2352x1568px, retinal fundus photograph
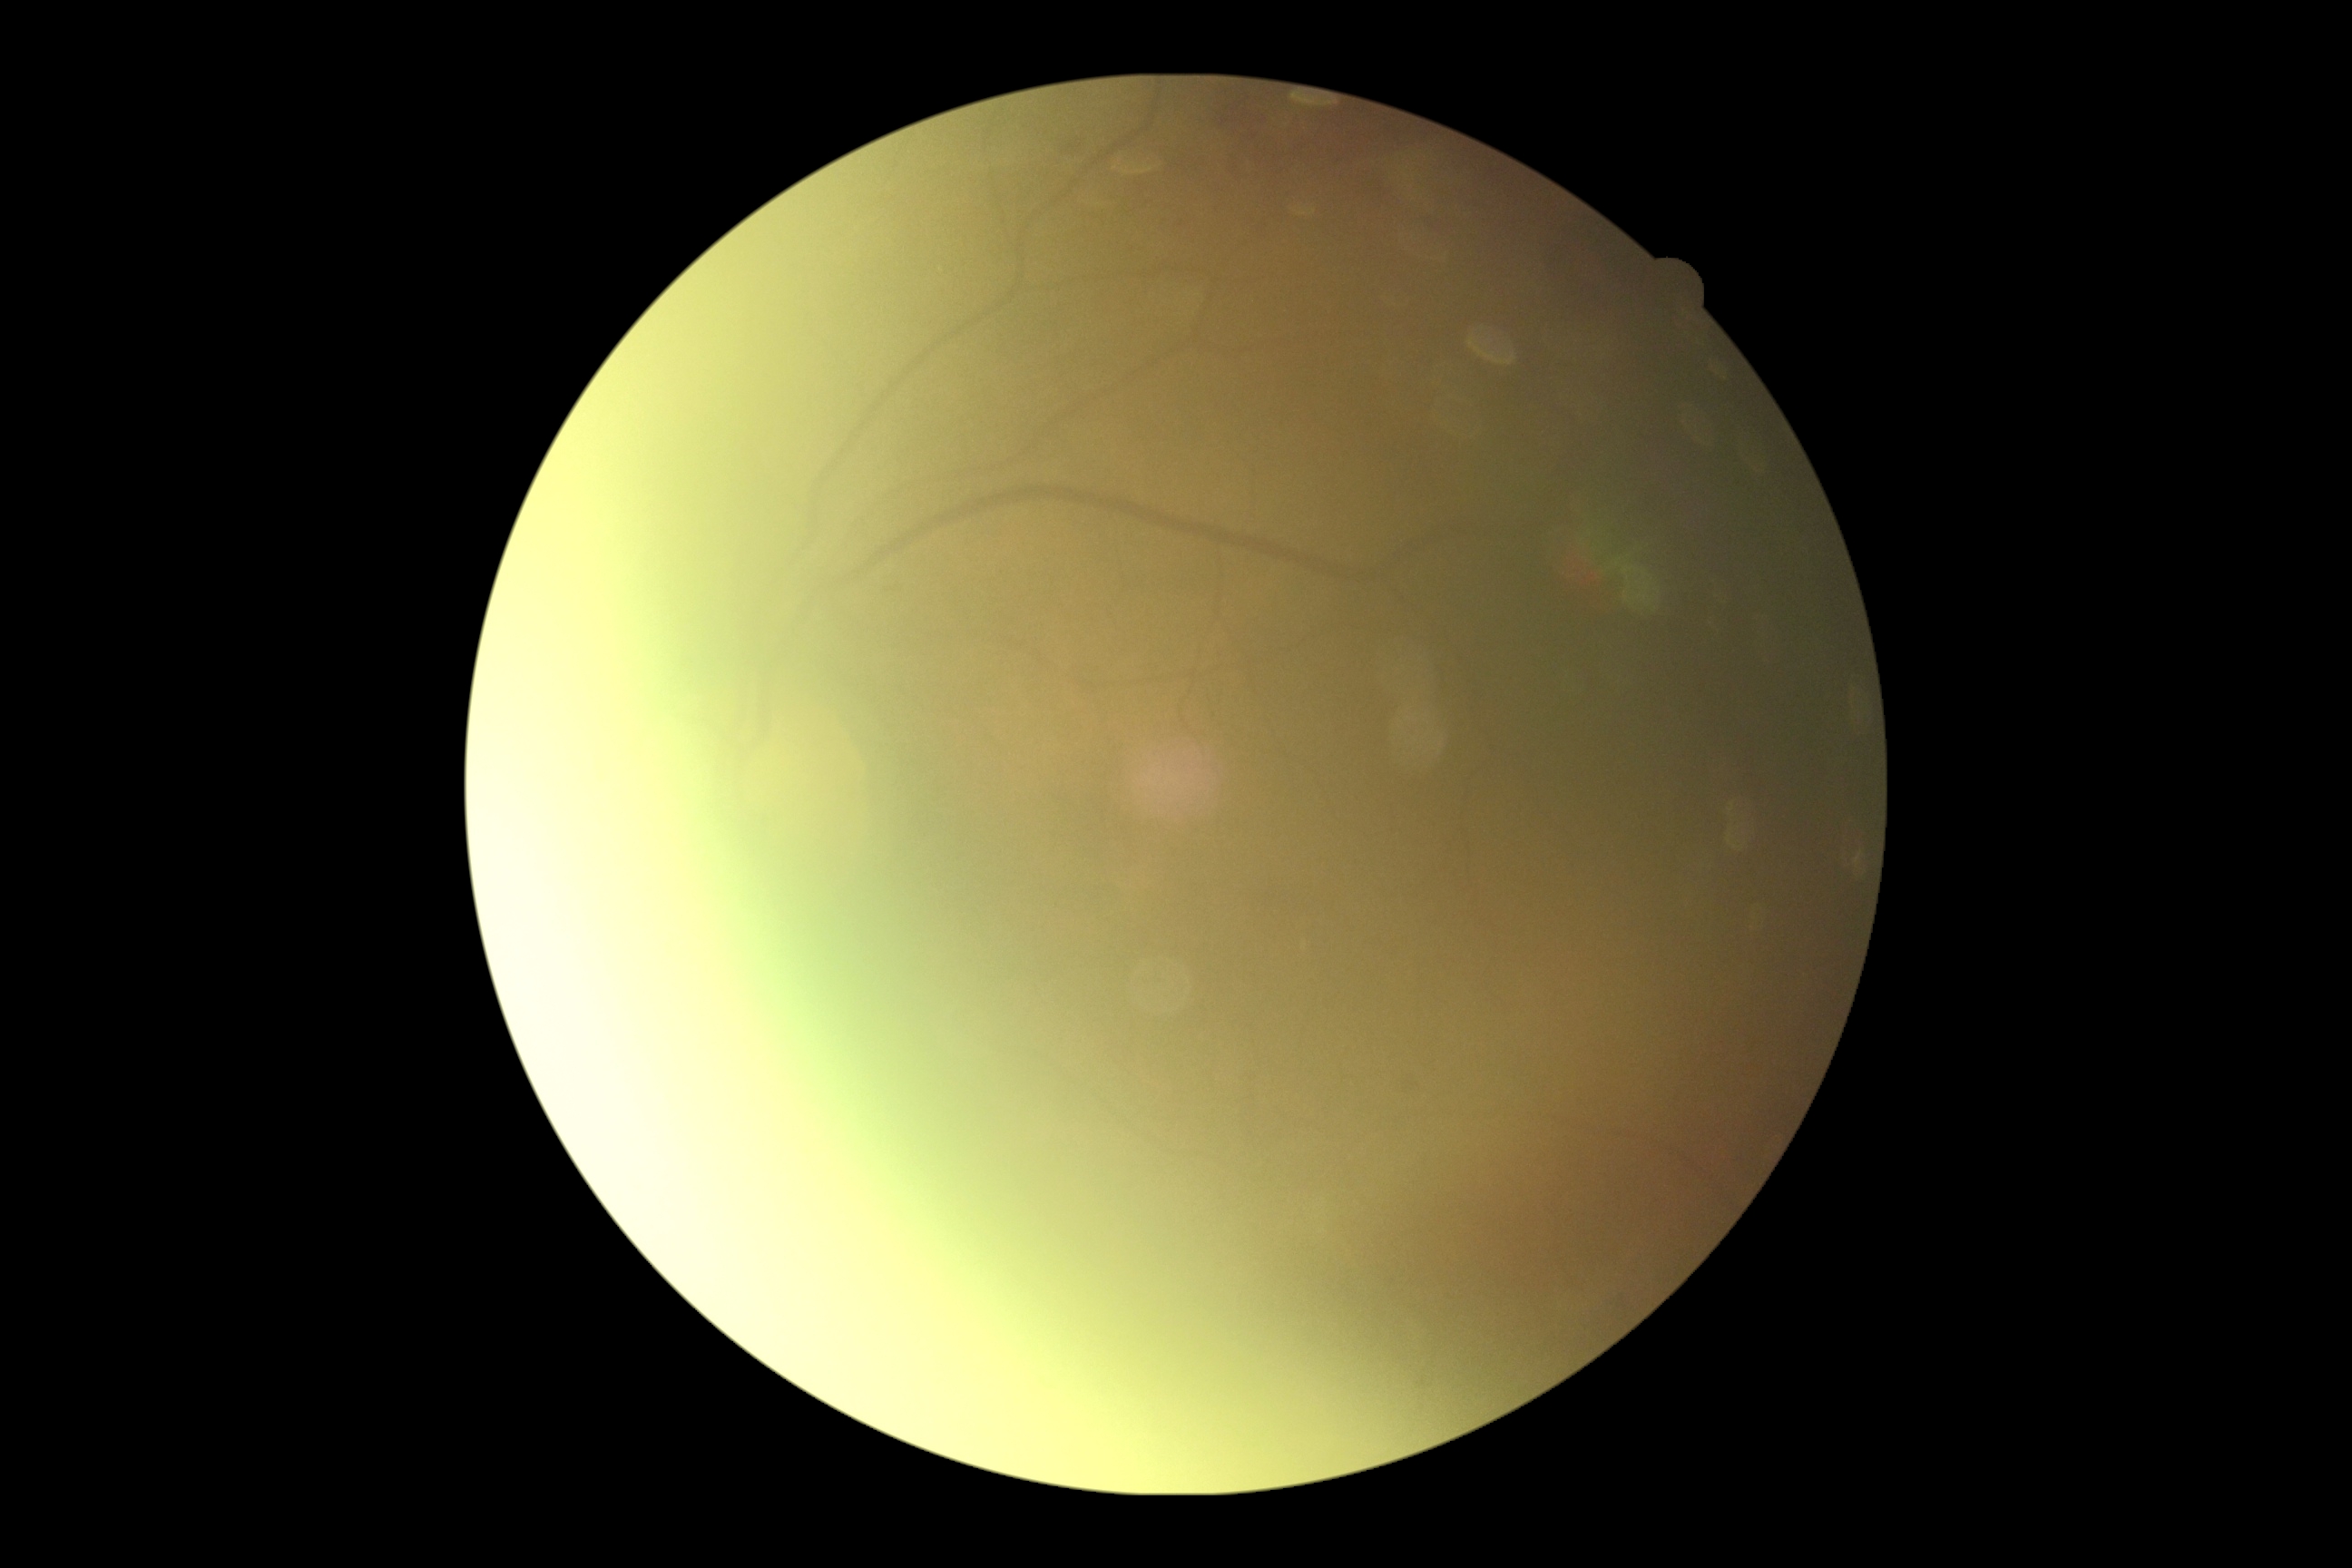 {"quality": "insufficient", "dr_grade": "ungradable"}